Ultra-widefield fundus mosaic; 200° FOV.
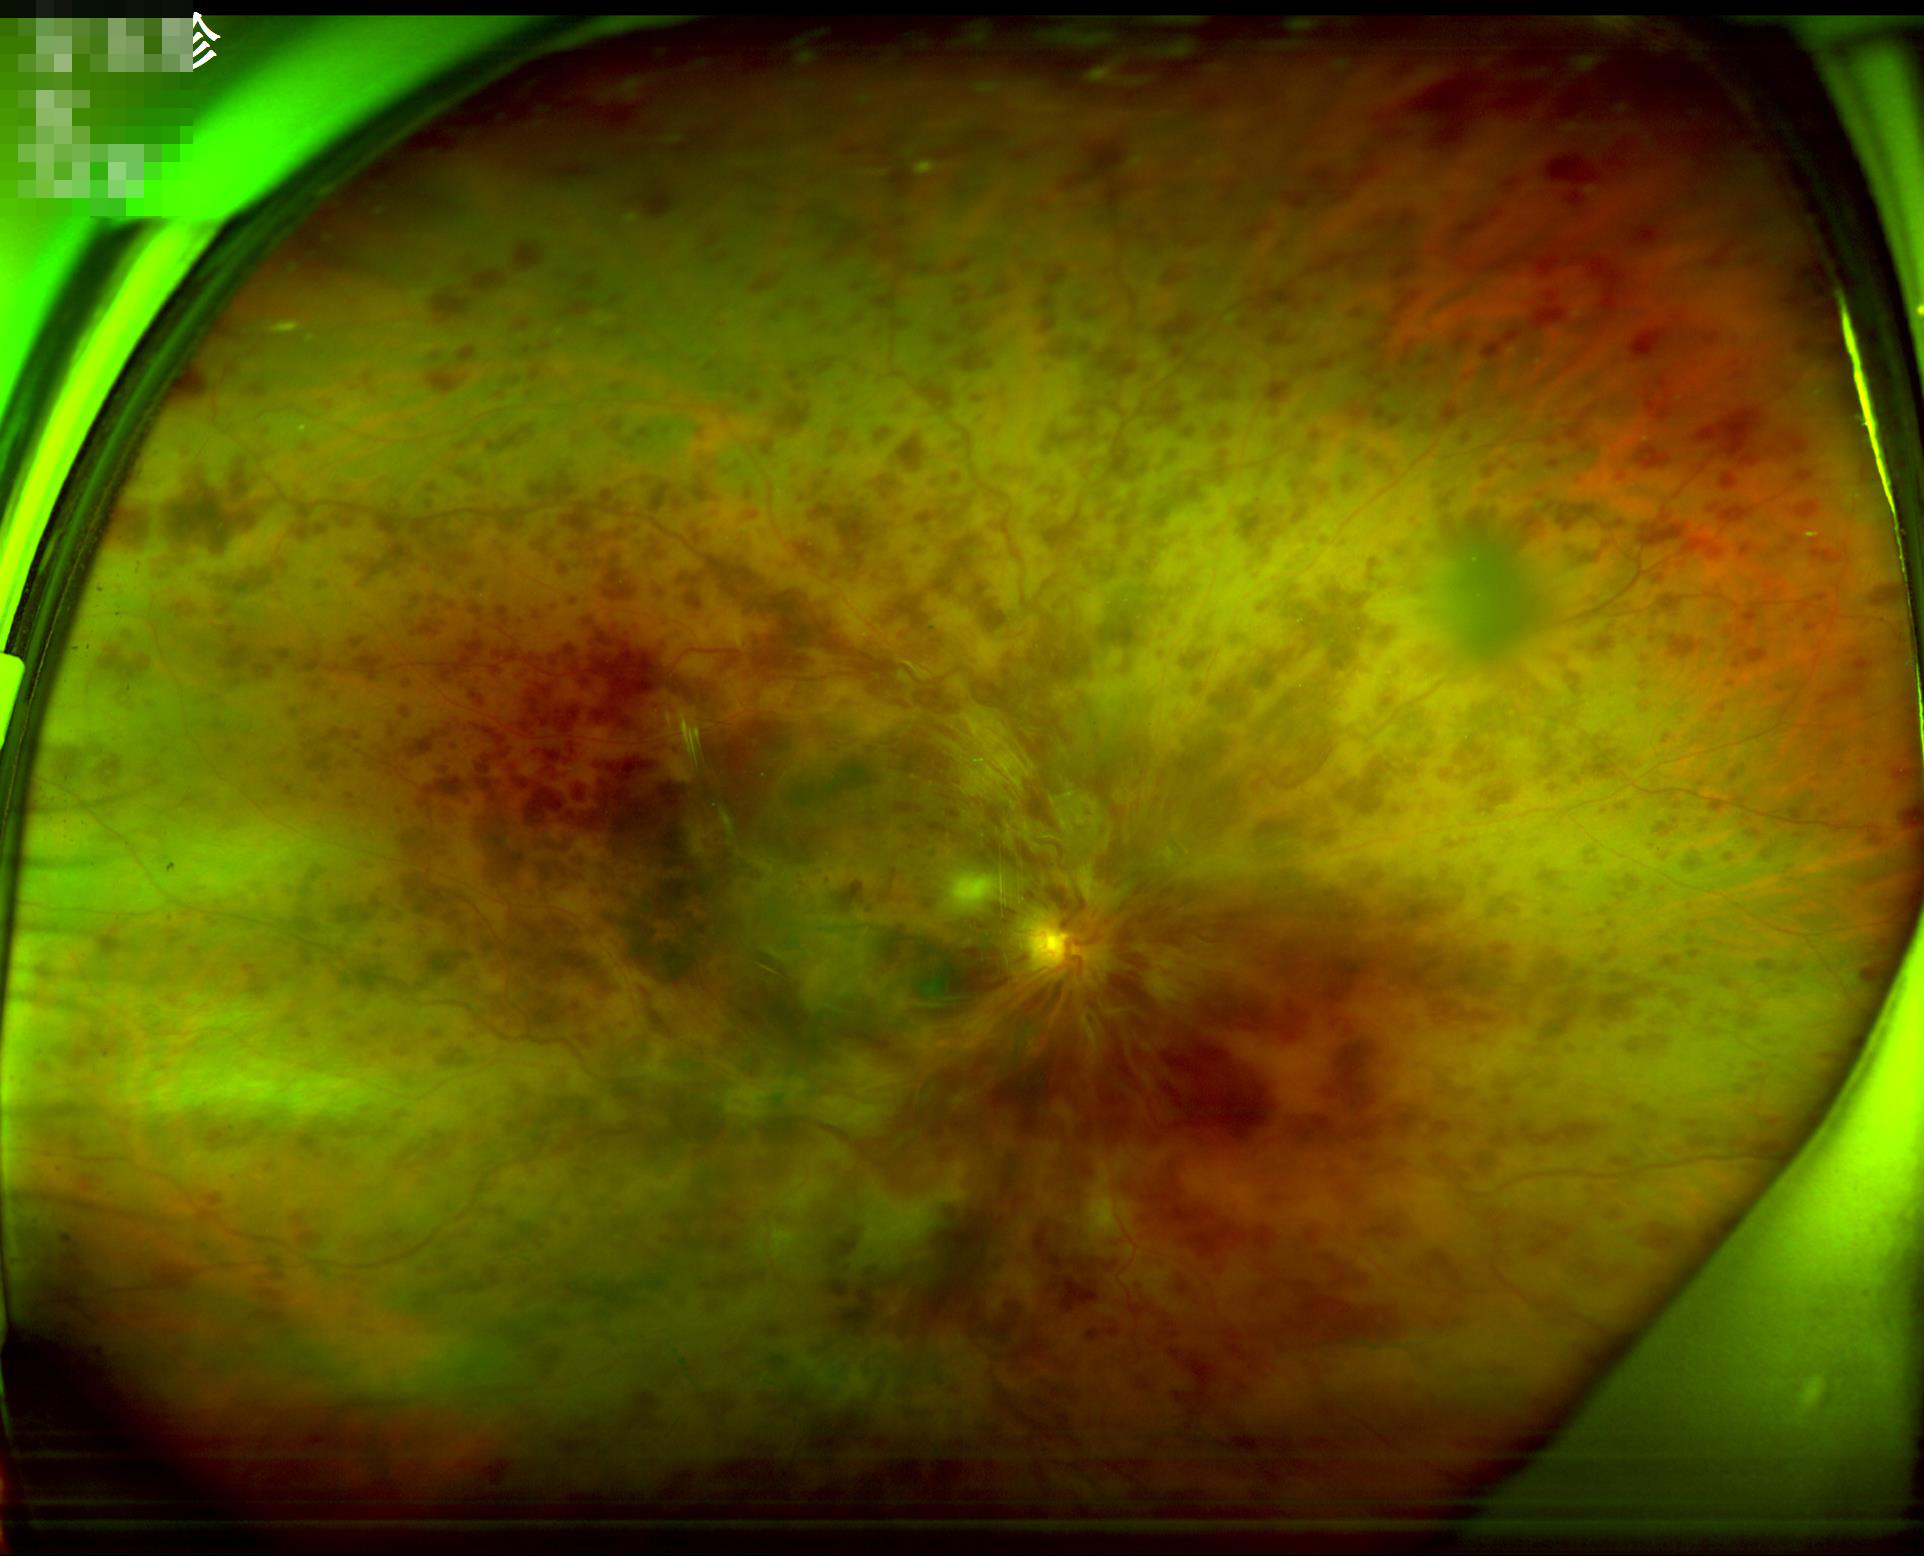 Overall image quality is poor. Contrast is low.